NIDEK AFC-230 fundus camera · Davis DR grading · without pupil dilation
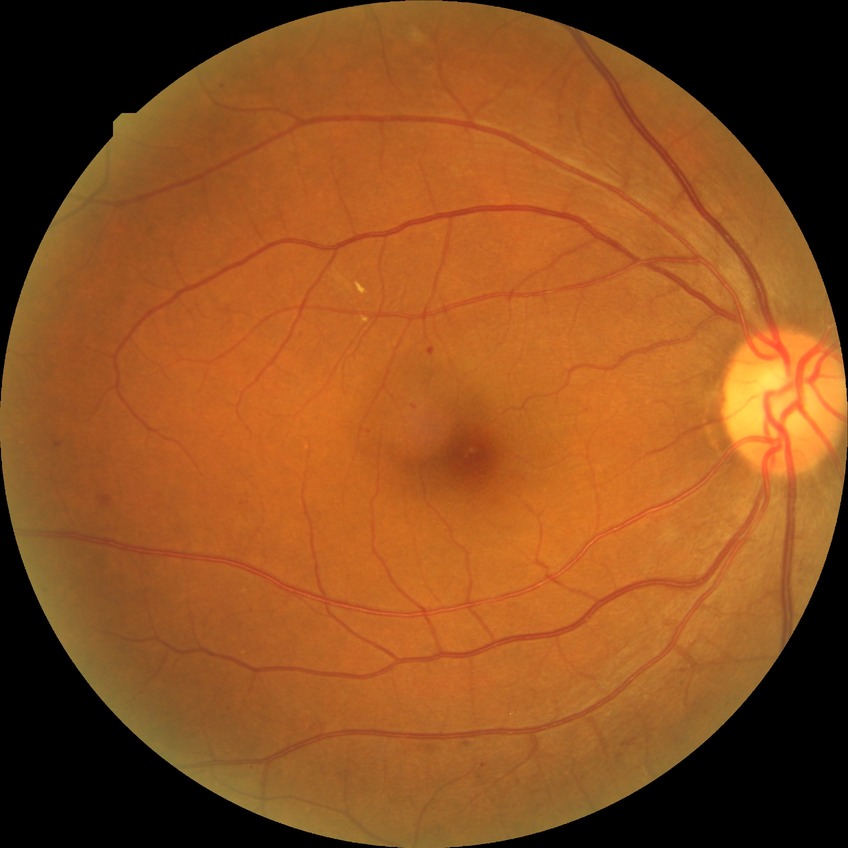 Davis DR grade is SDR. The retinopathy is classified as non-proliferative diabetic retinopathy.